Handheld portable fundus camera image. Image size 2212x1659.
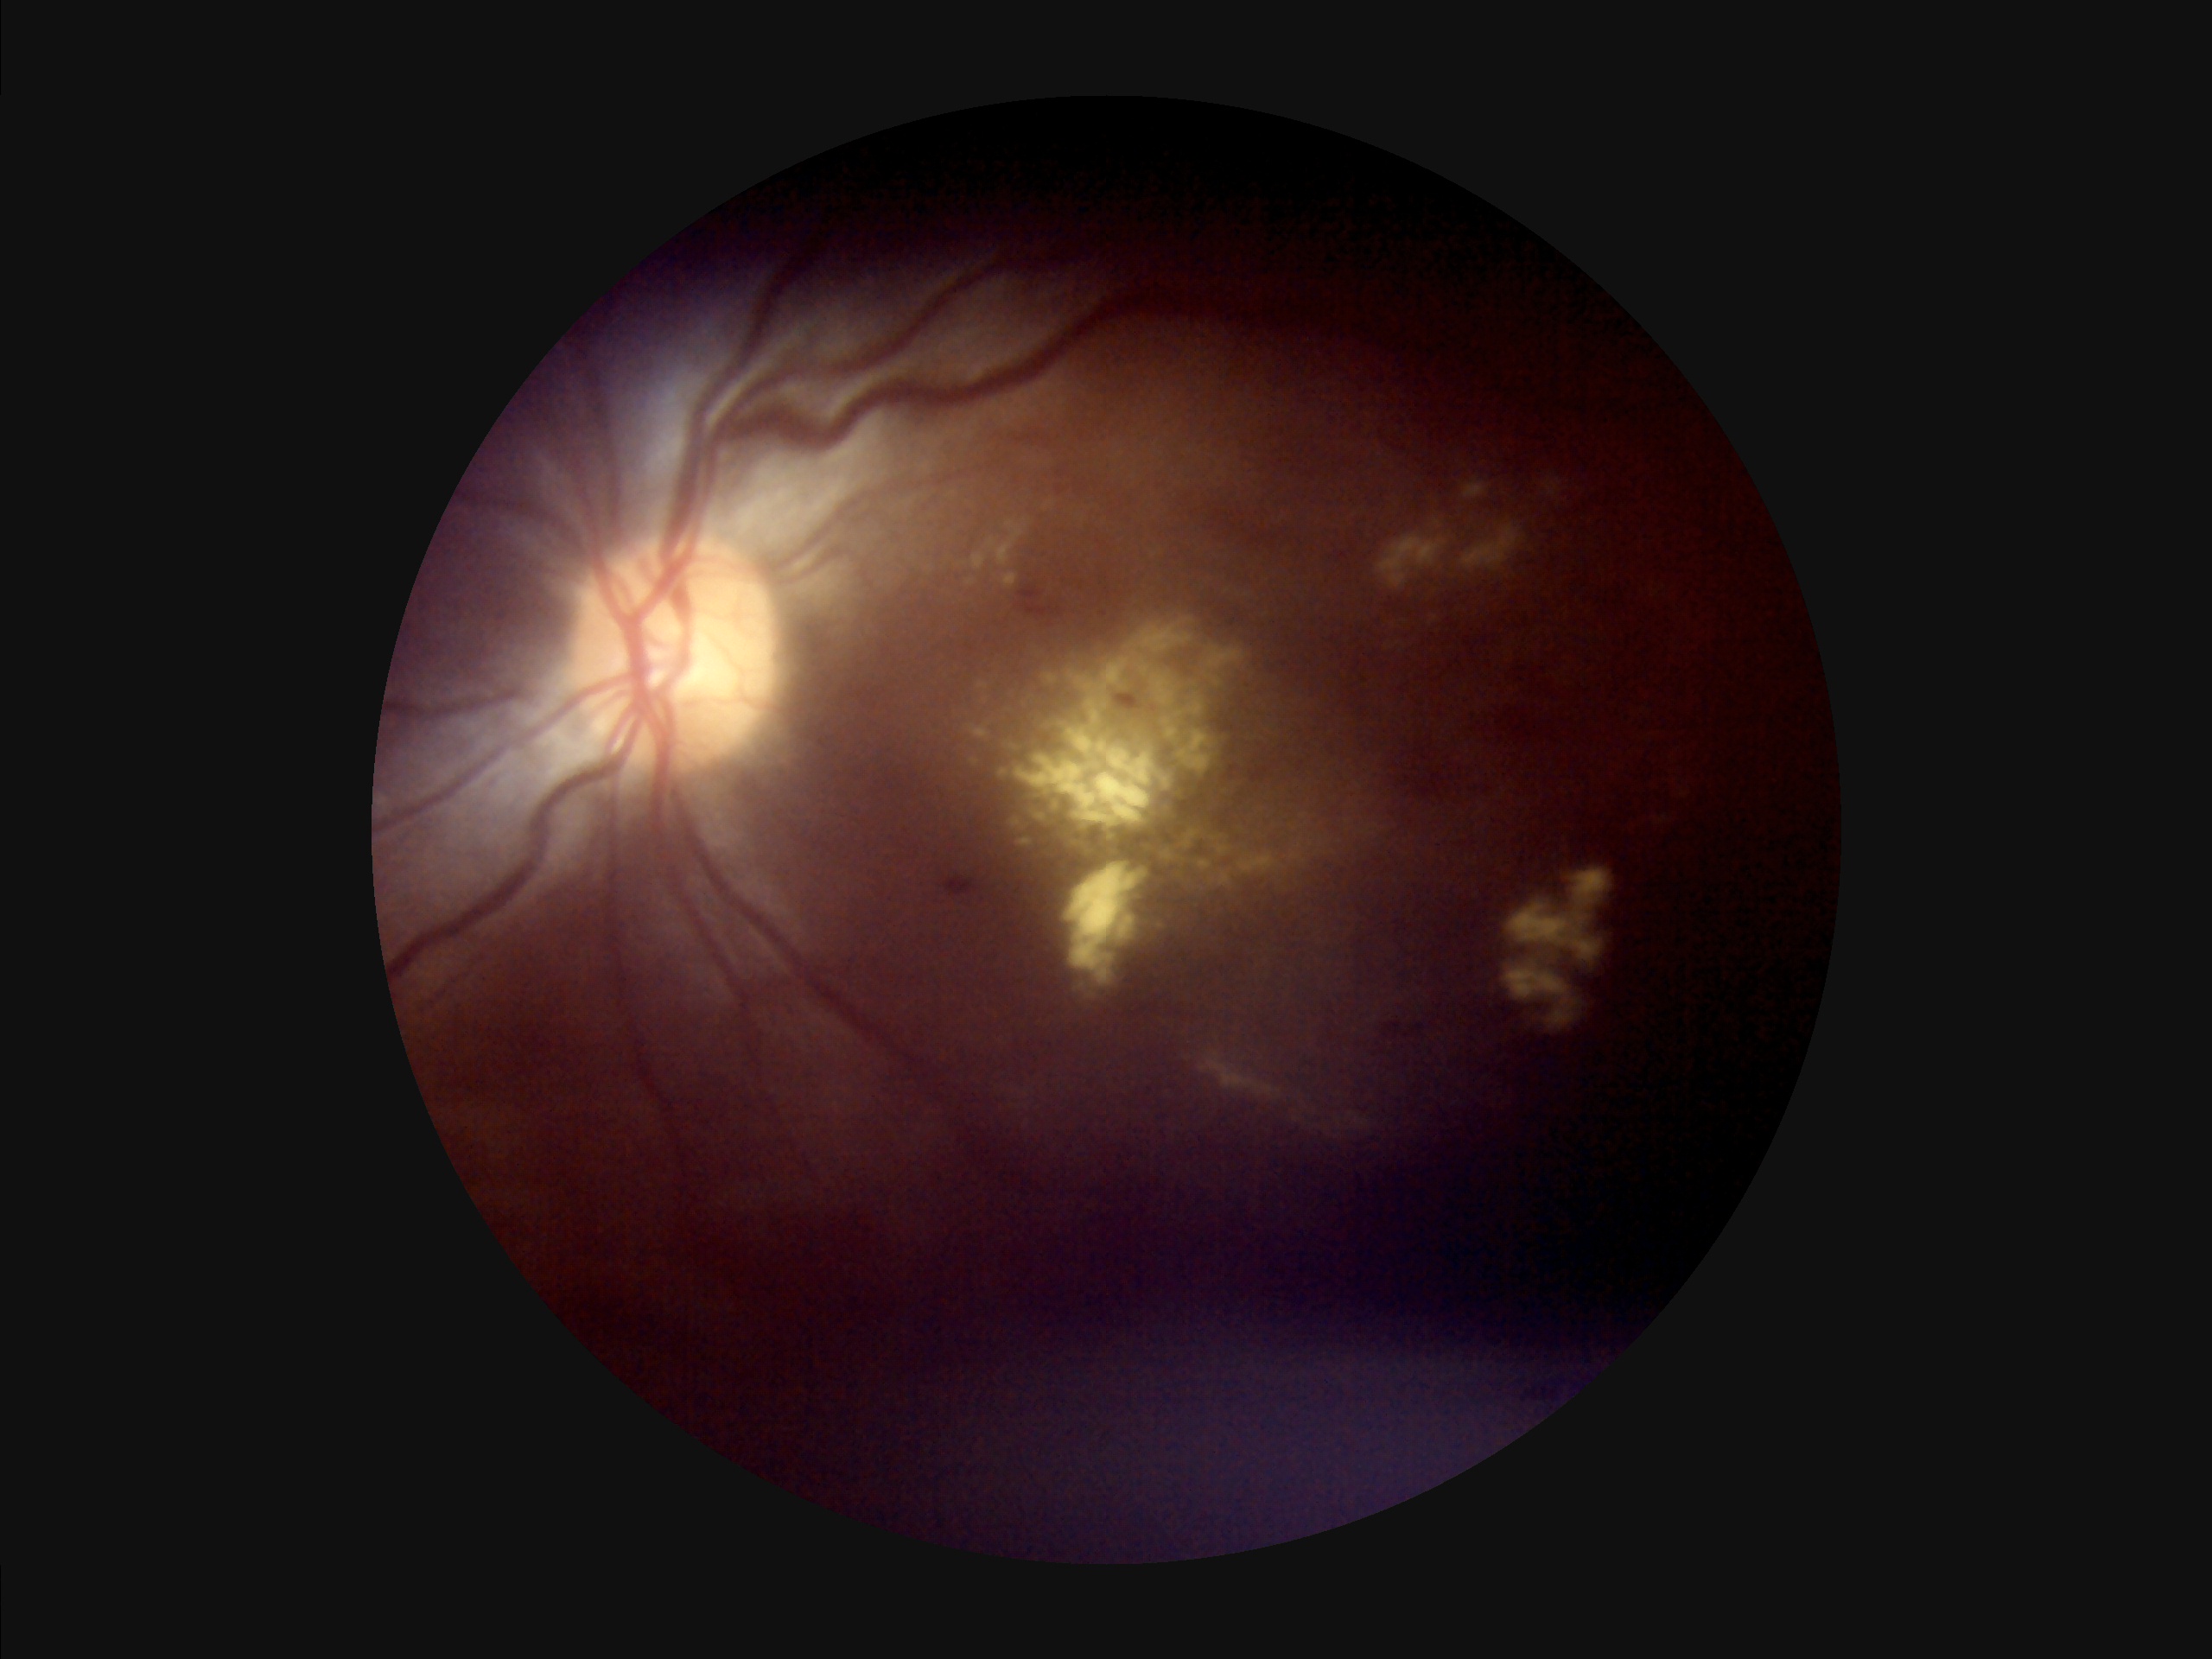
Illumination: uneven
Overall image quality: inadequate
Contrast: low
Focus: poor